Modified Davis grading:
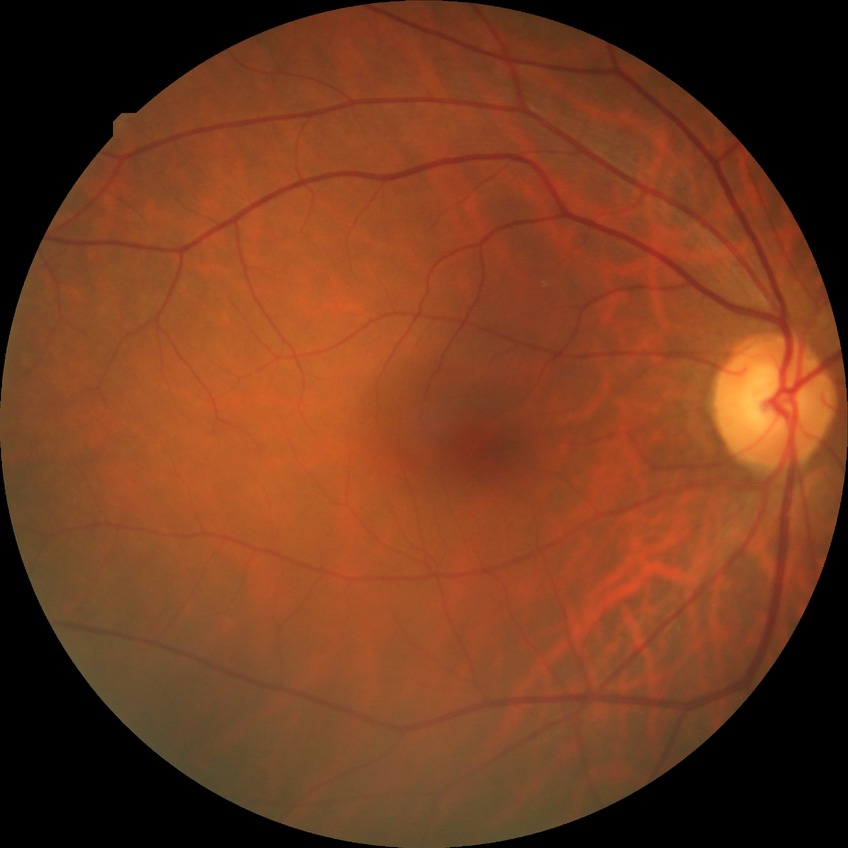

Davis grading is no diabetic retinopathy.